Fundus photo. 45 degree fundus photograph
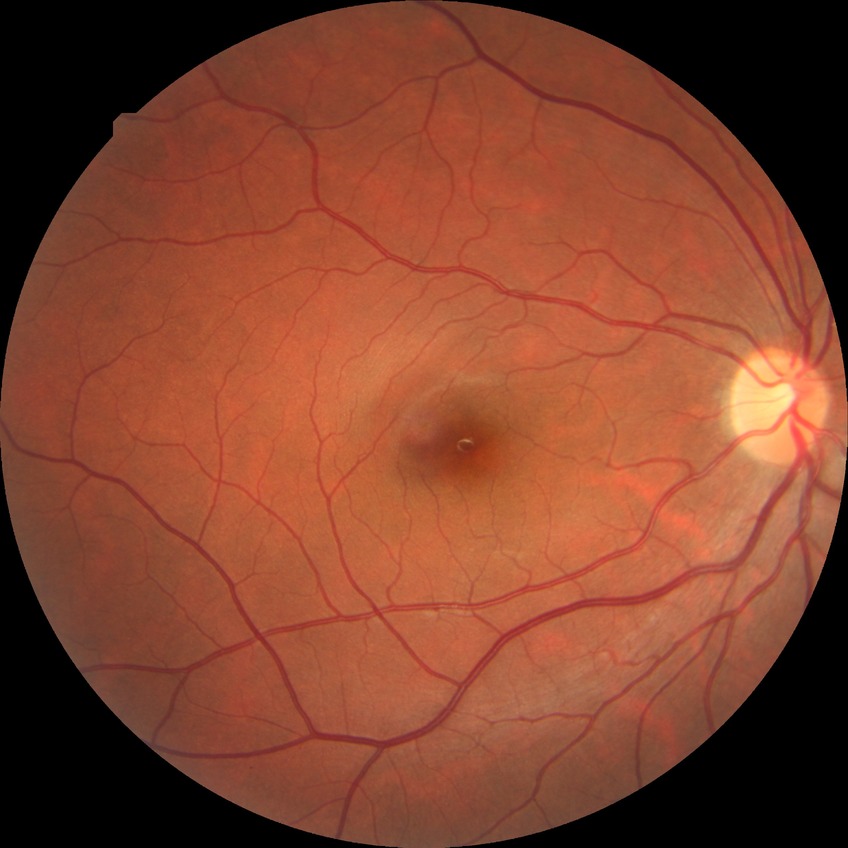 Davis grading is no diabetic retinopathy.